Posterior pole photograph, graded on the modified Davis scale.
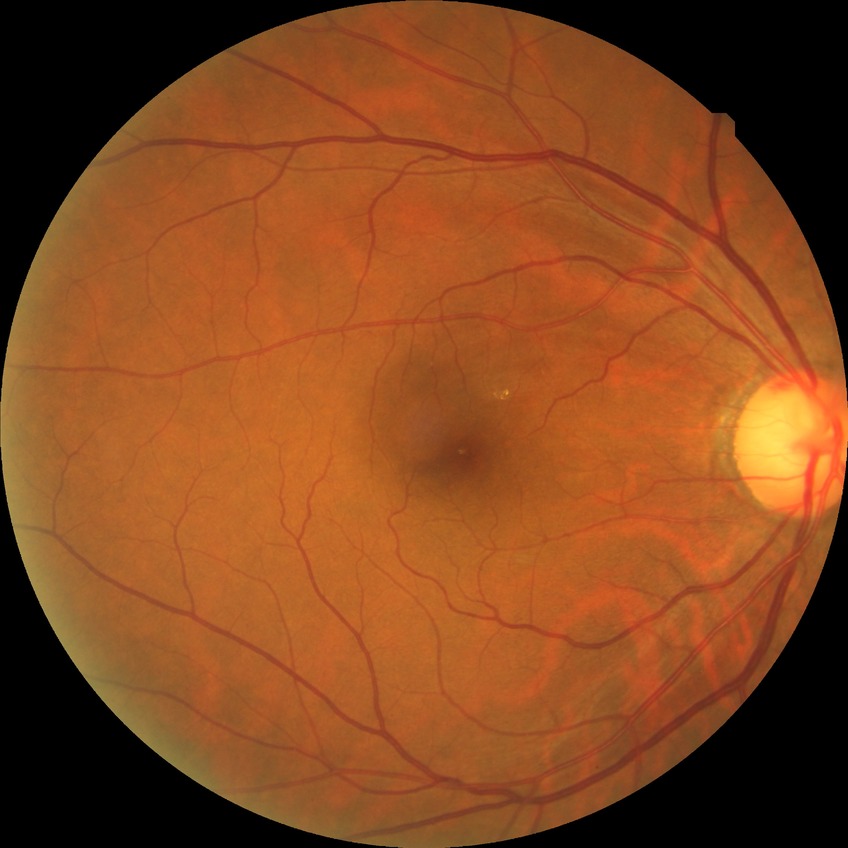 davis_grade: no diabetic retinopathy (NDR)